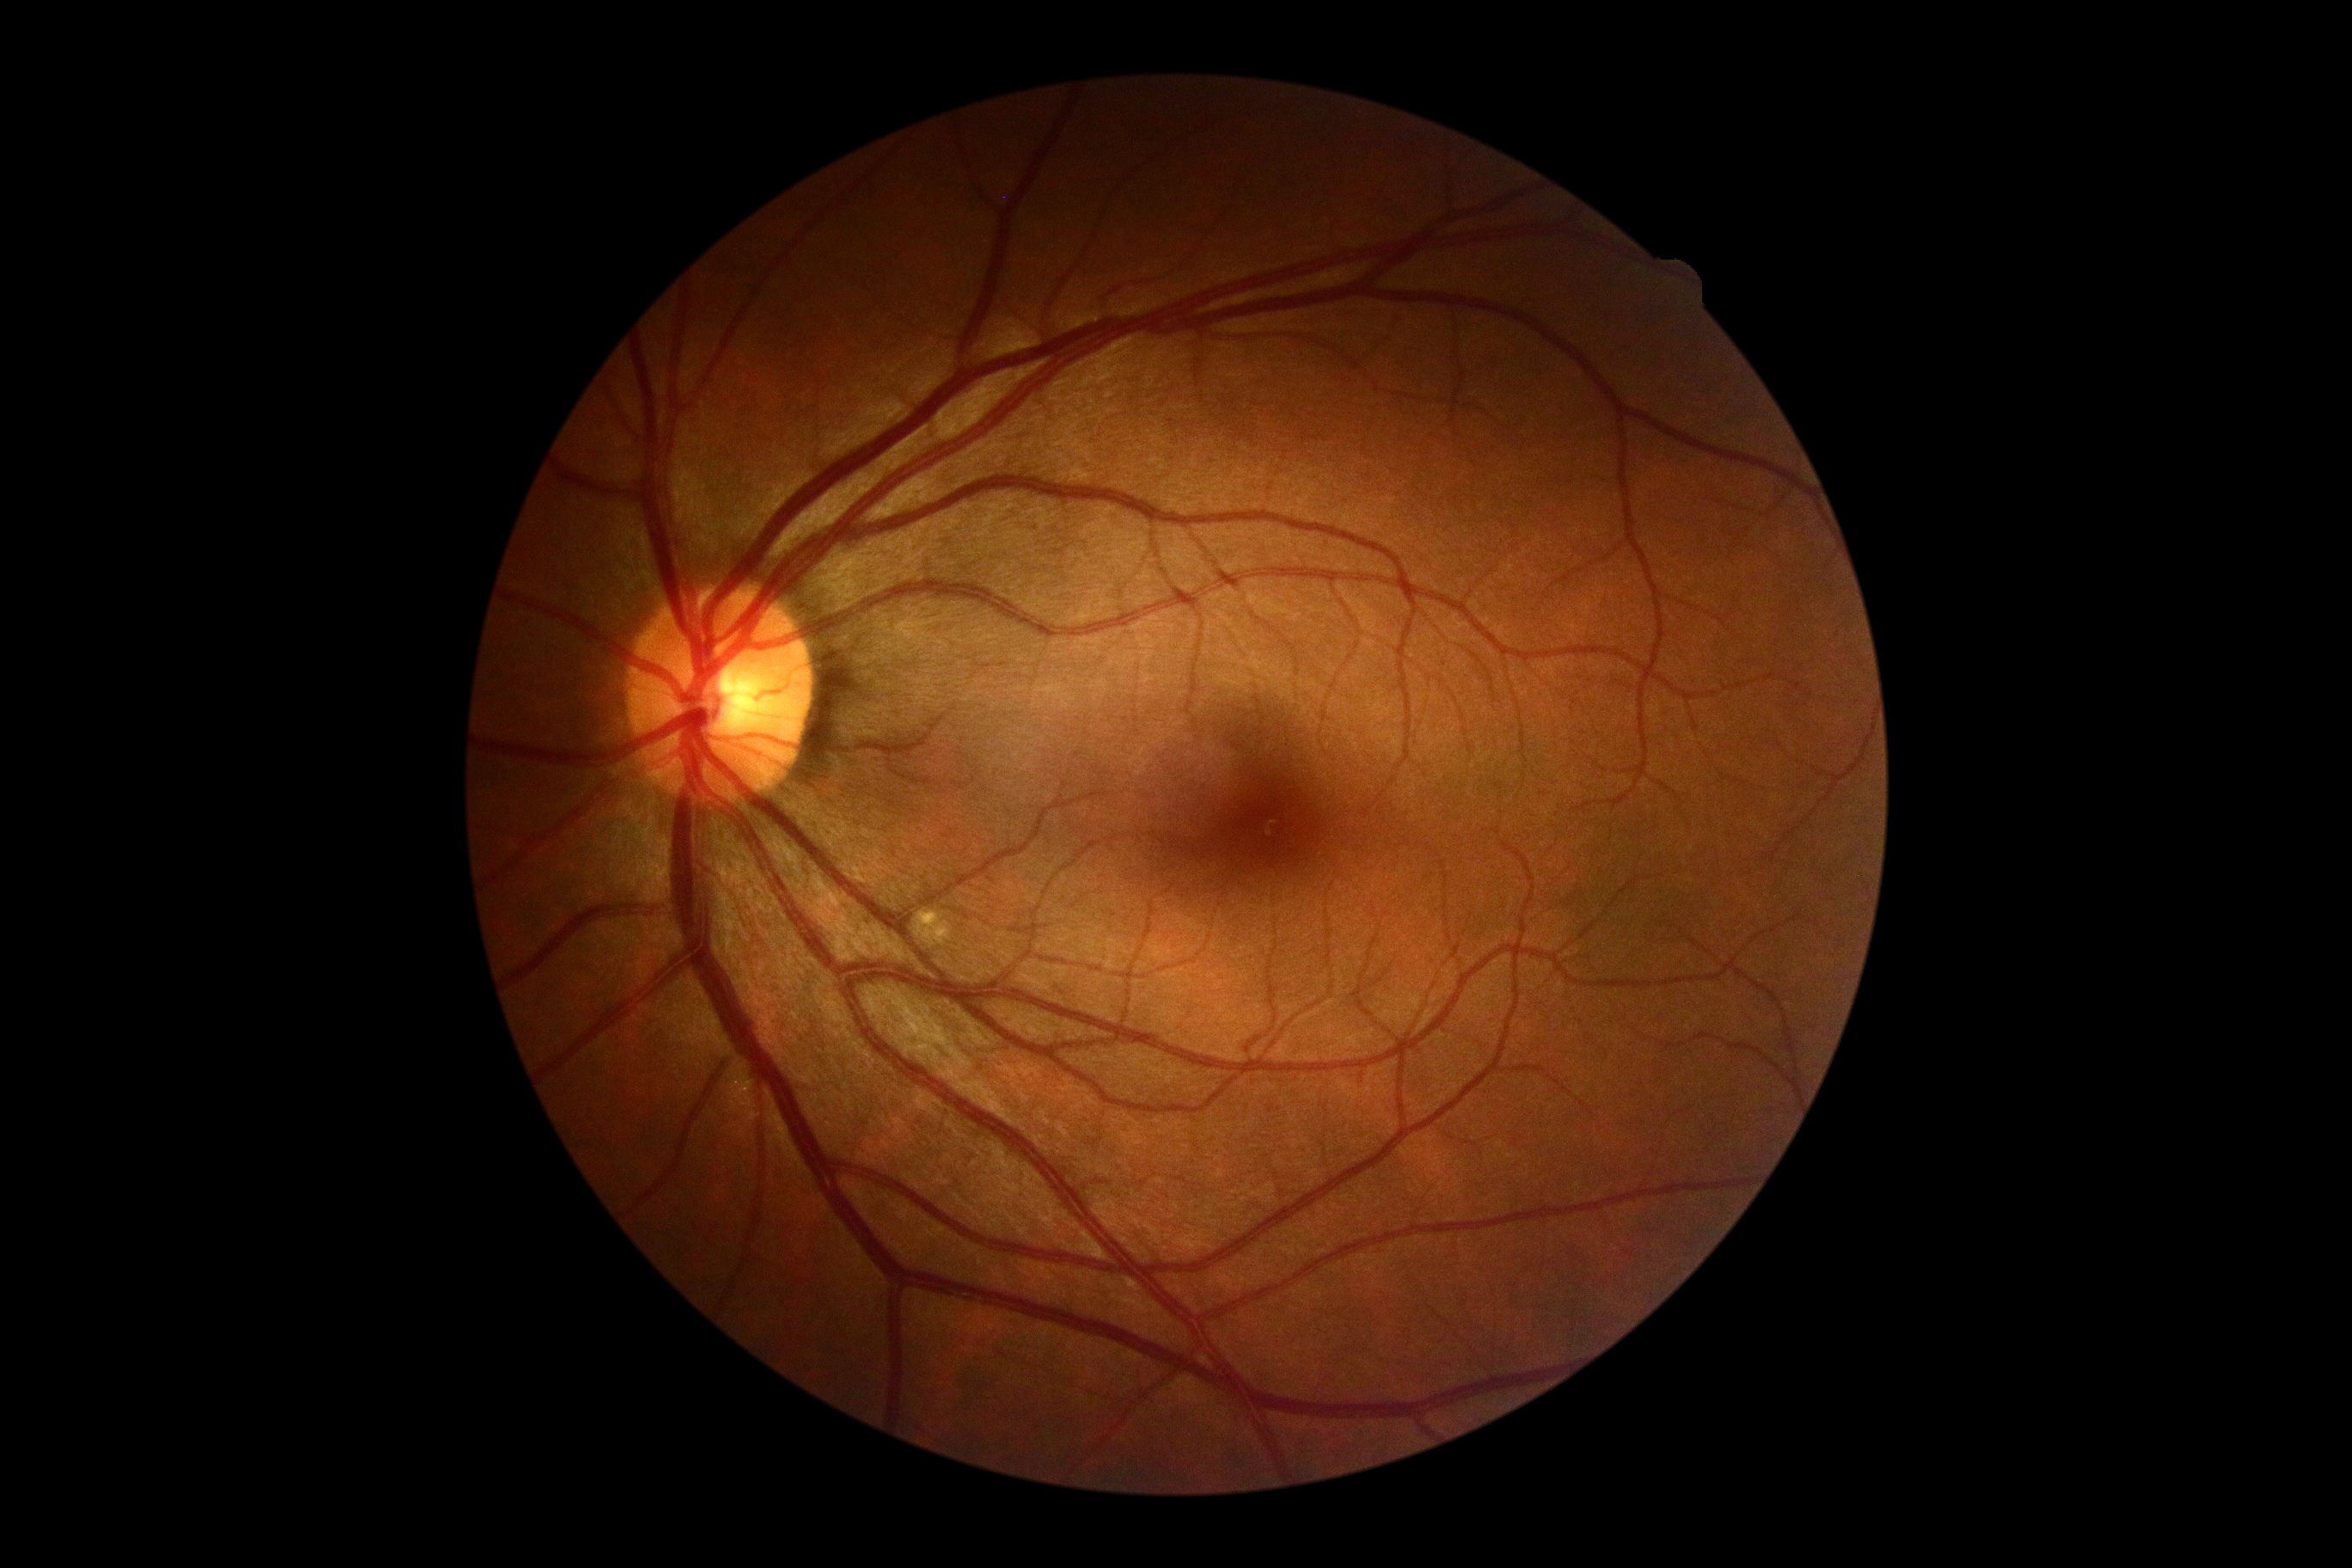

{
  "dr_grade": "0"
}